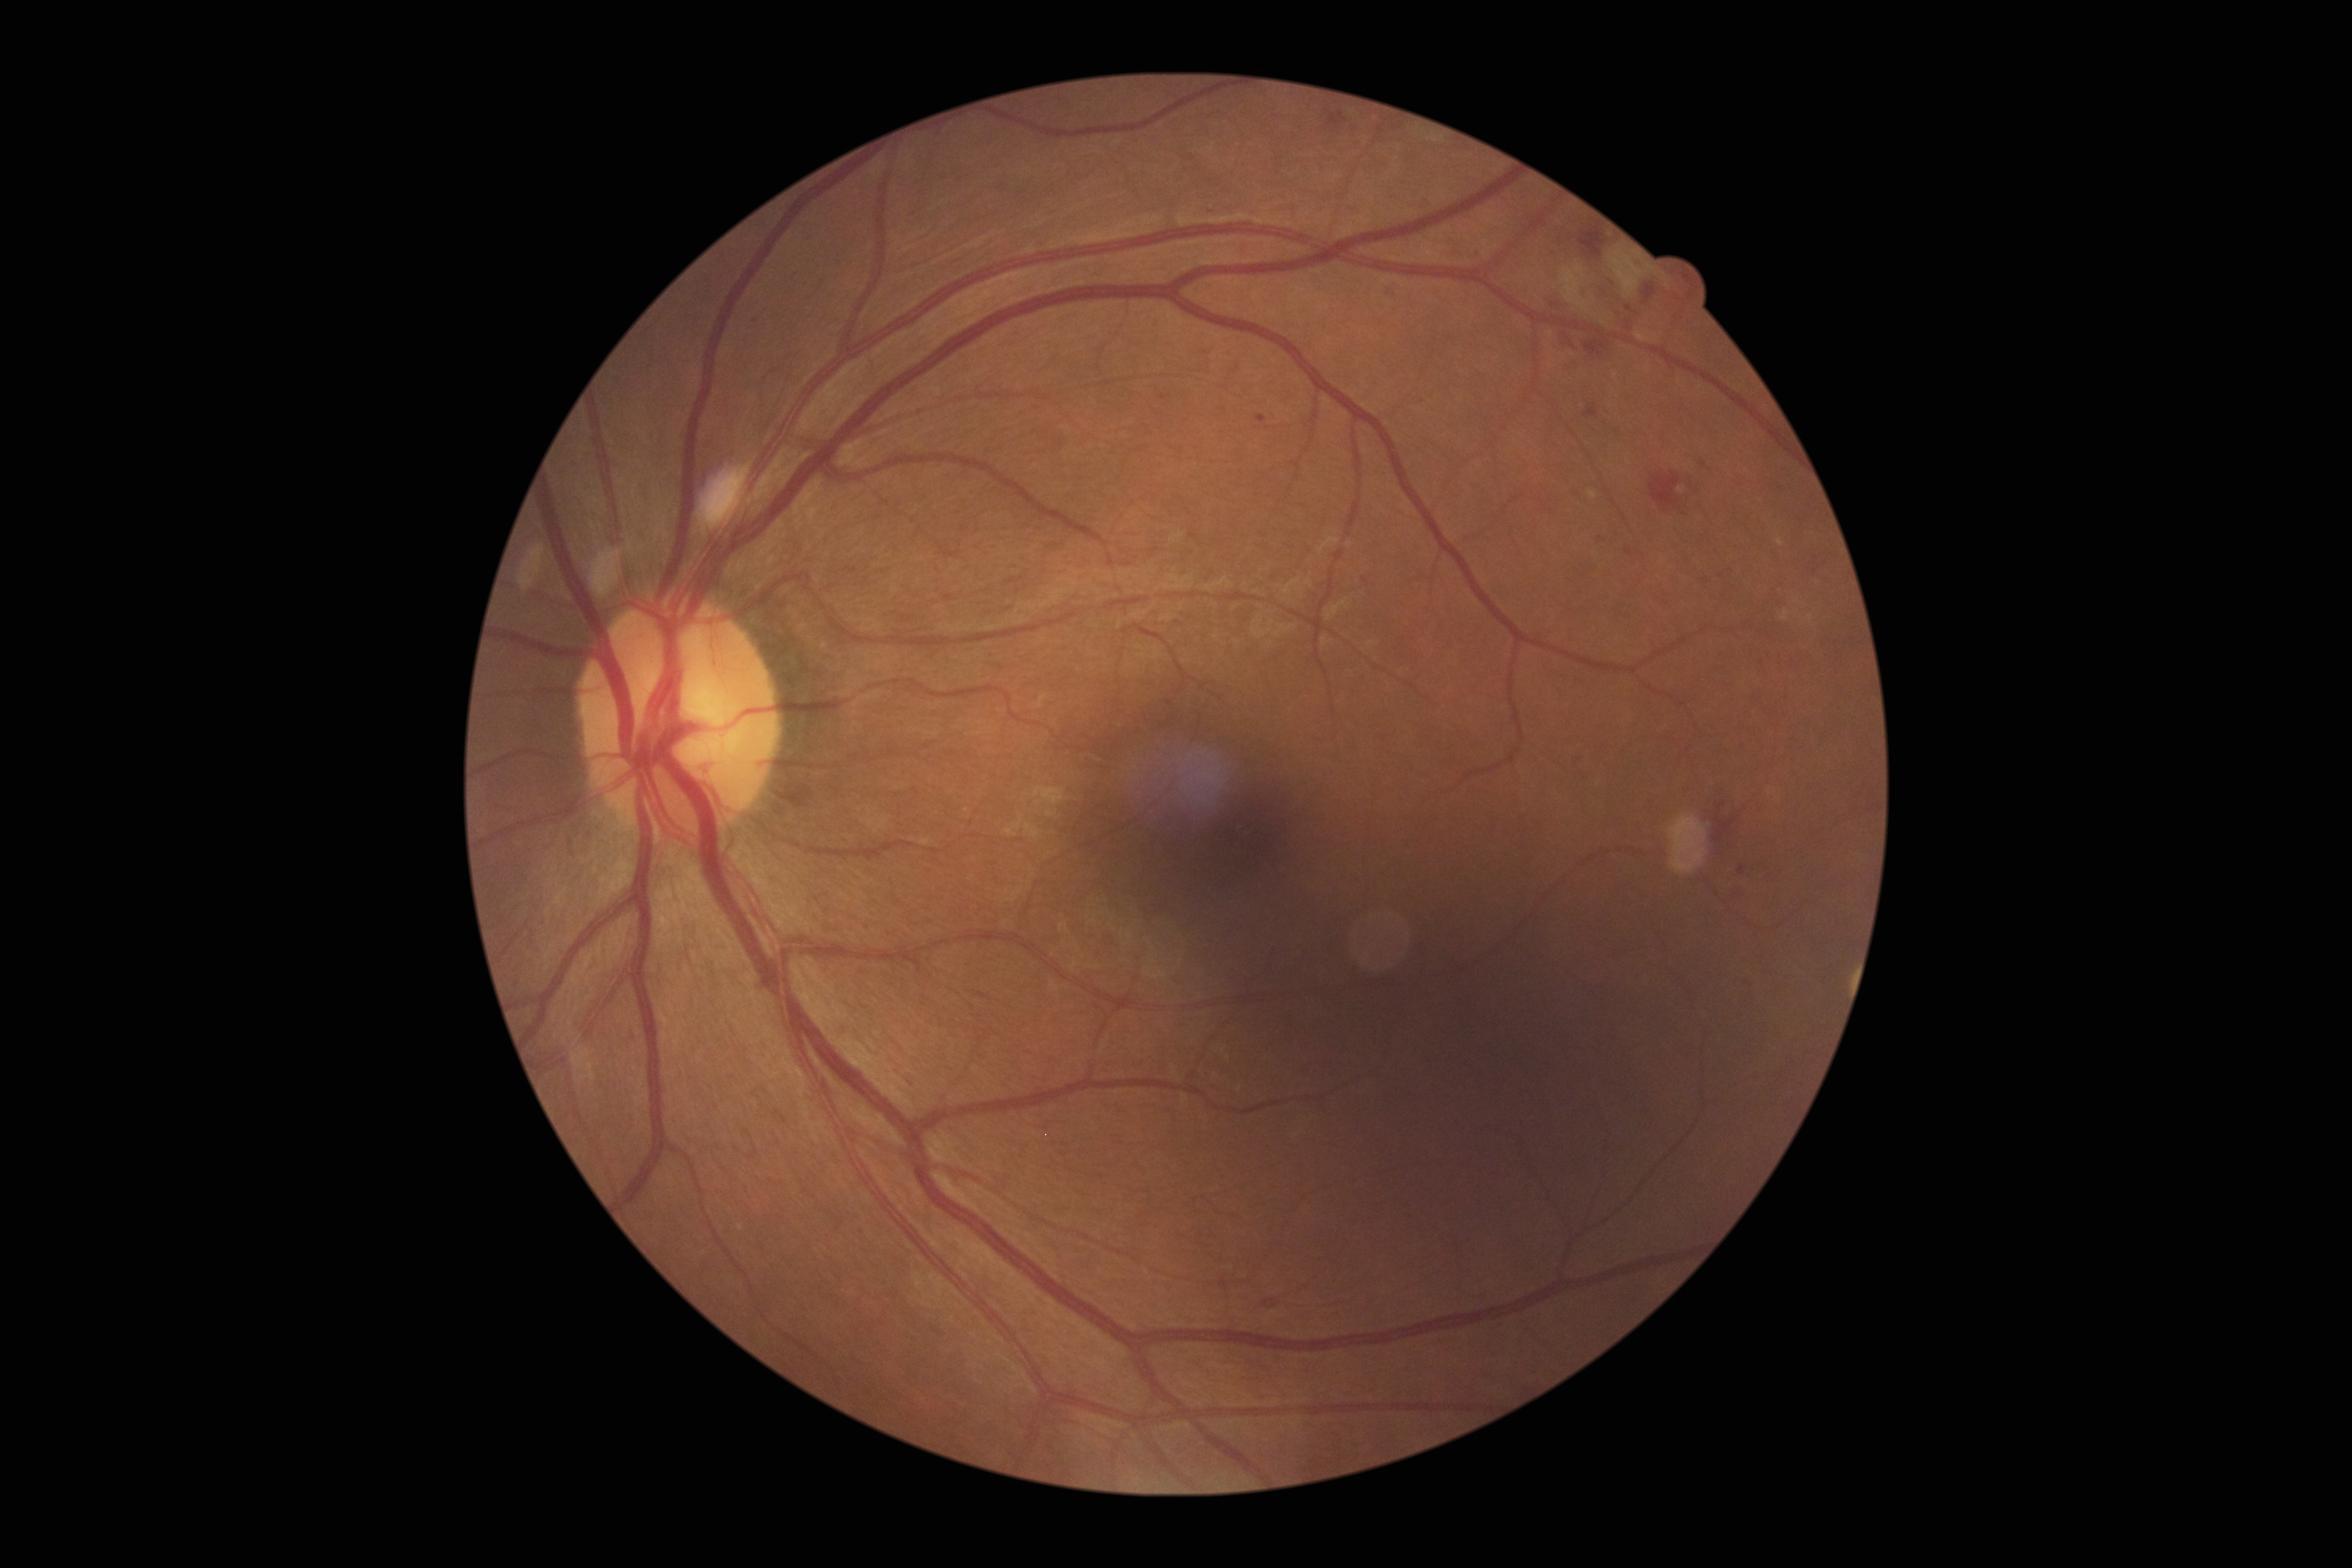

– diabetic retinopathy grade — 2 (moderate NPDR) — more than just microaneurysms but less than severe NPDR